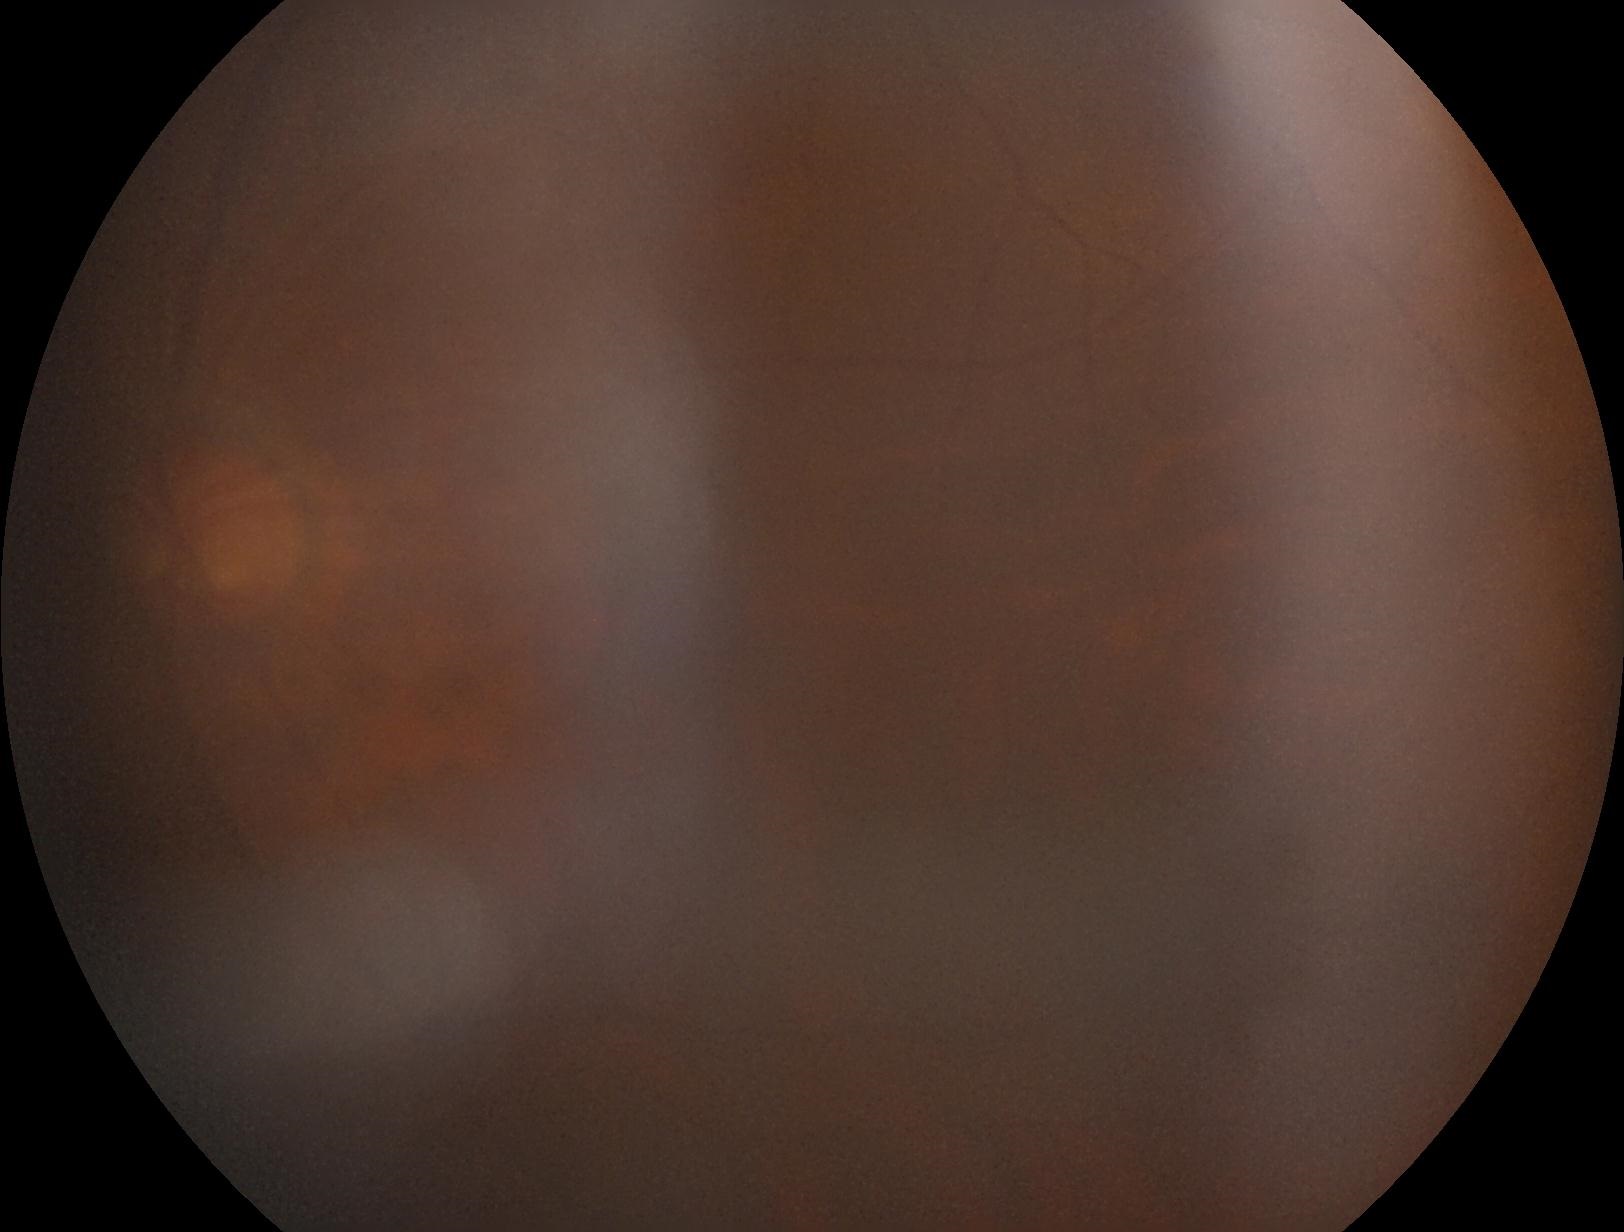
{
  "dr_grade": "ungradable due to poor image quality"
}